2352 x 1568 pixels · 45° field of view · retinal fundus photograph: 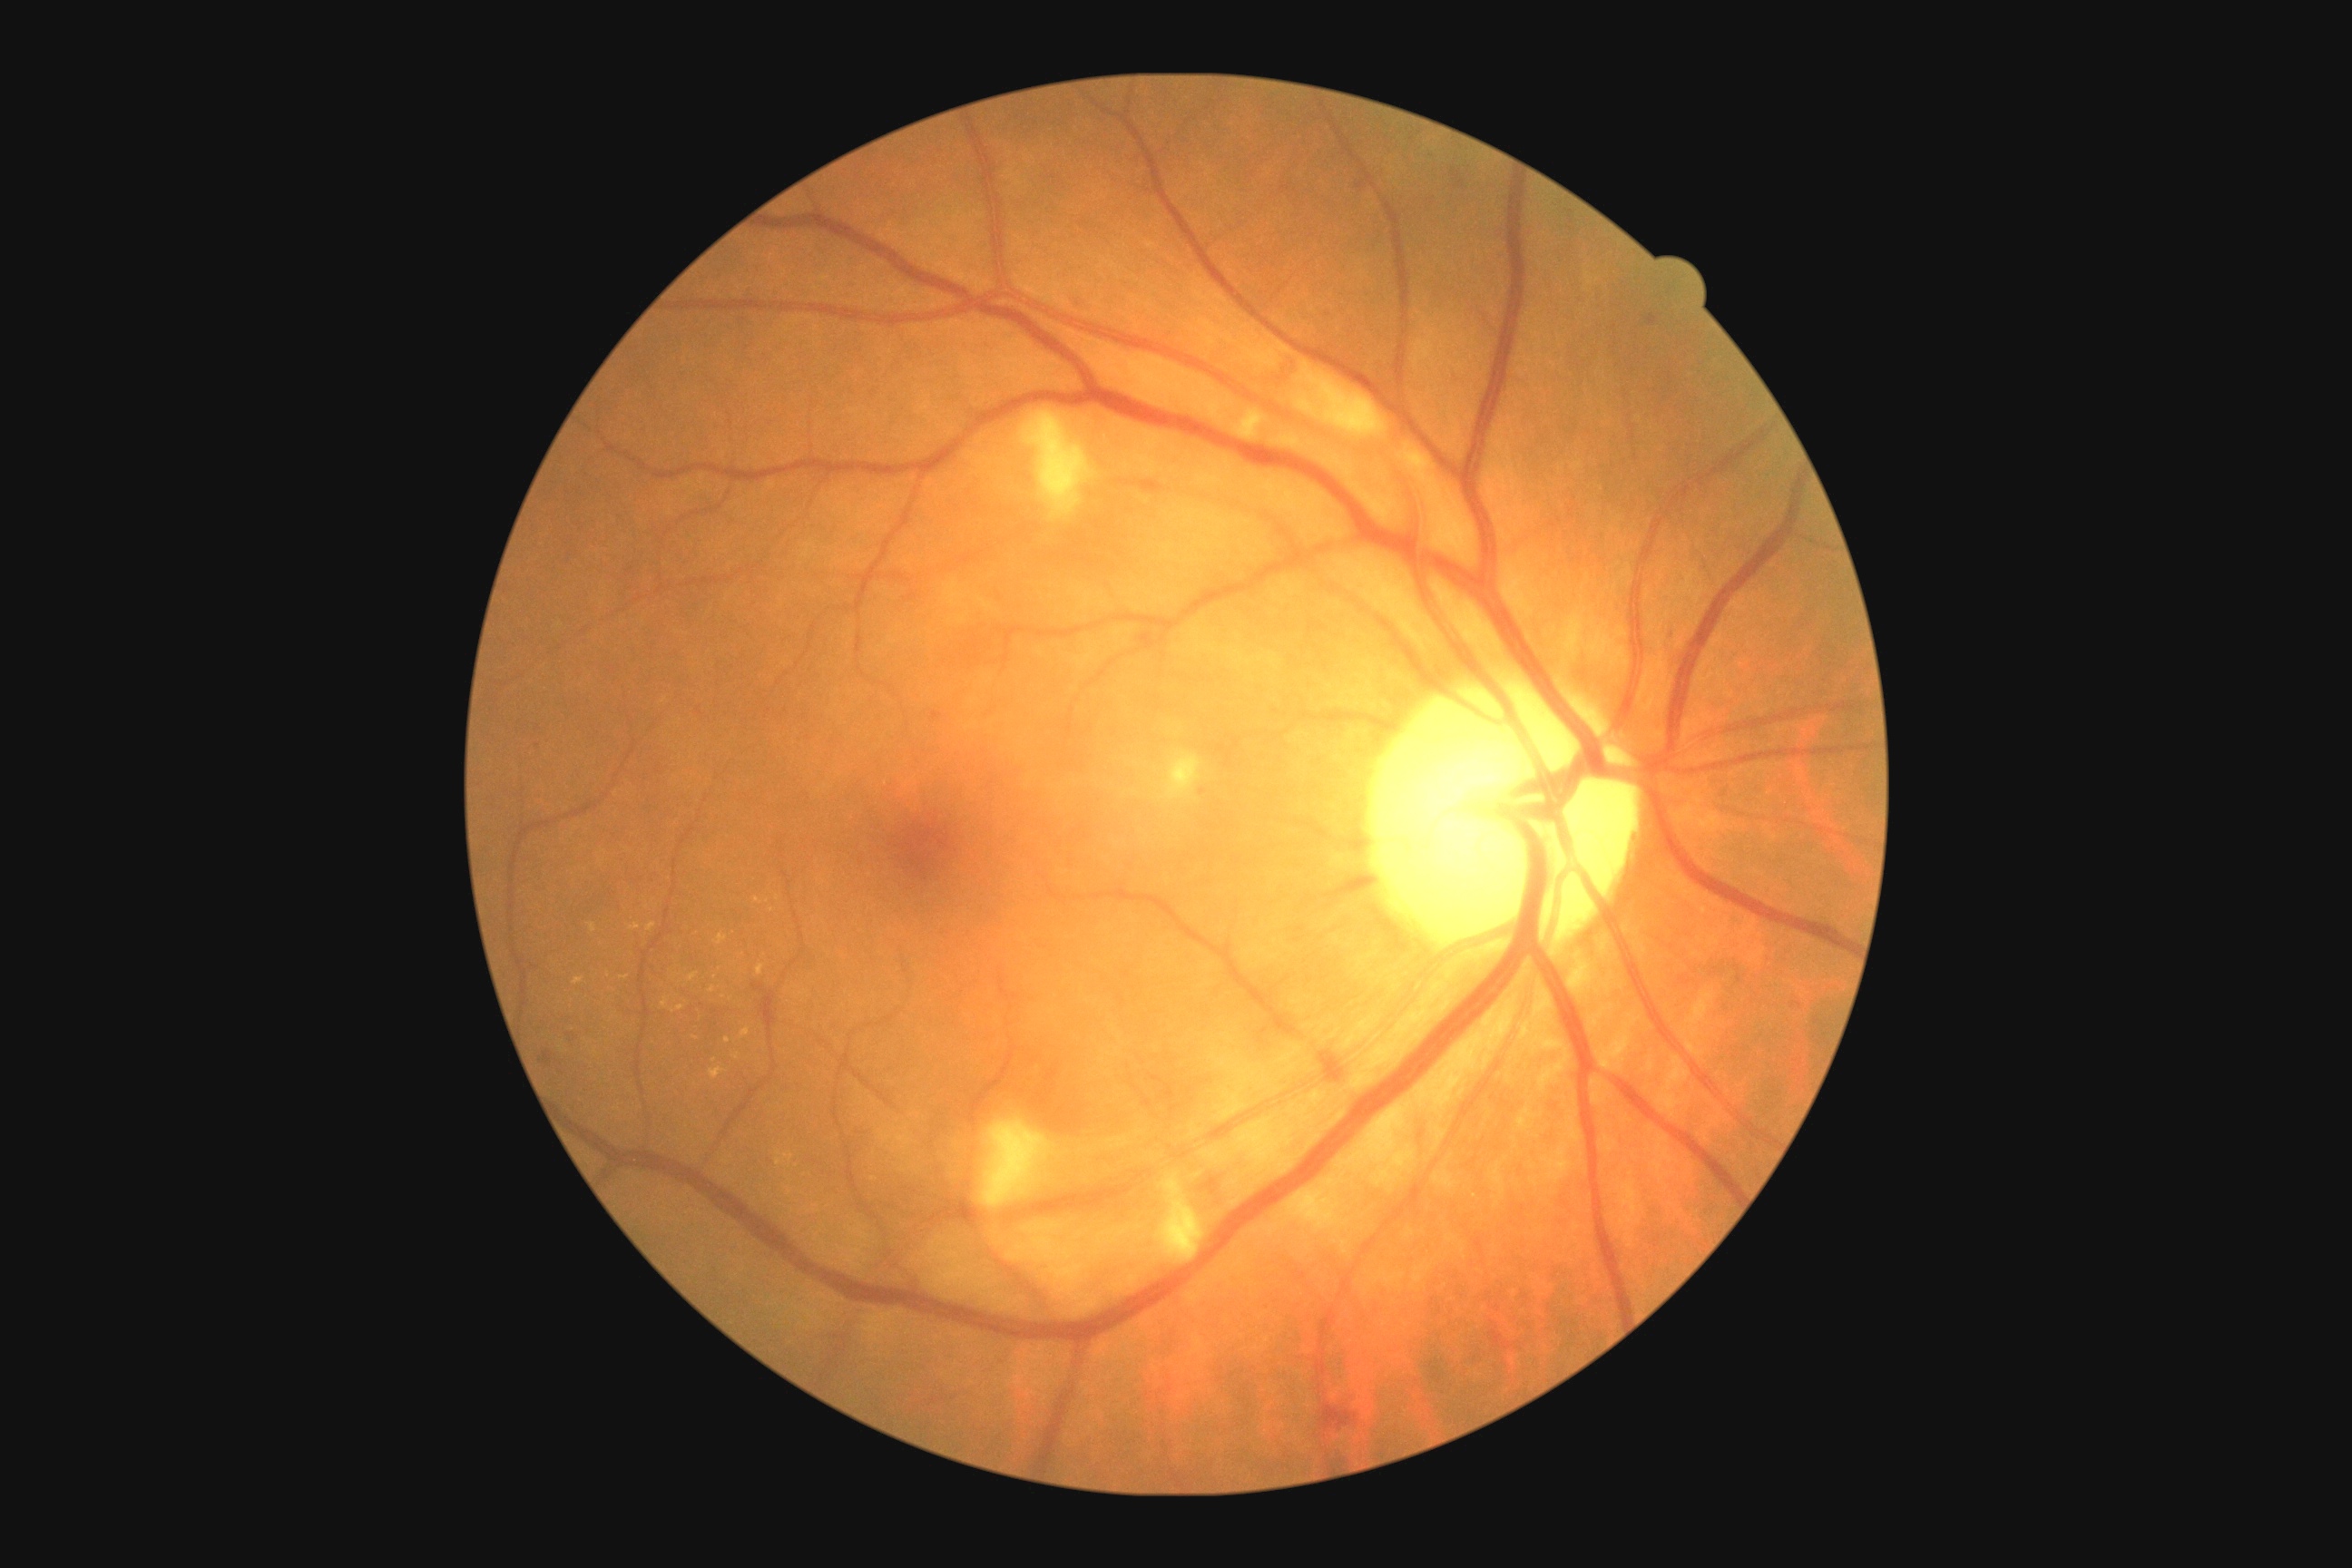 Findings:
– DR grade — 2
– DR class — non-proliferative diabetic retinopathy